Acquired with a NIDEK AFC-230; DR severity per modified Davis staging; color fundus image; nonmydriatic; 848x848; 45° FOV:
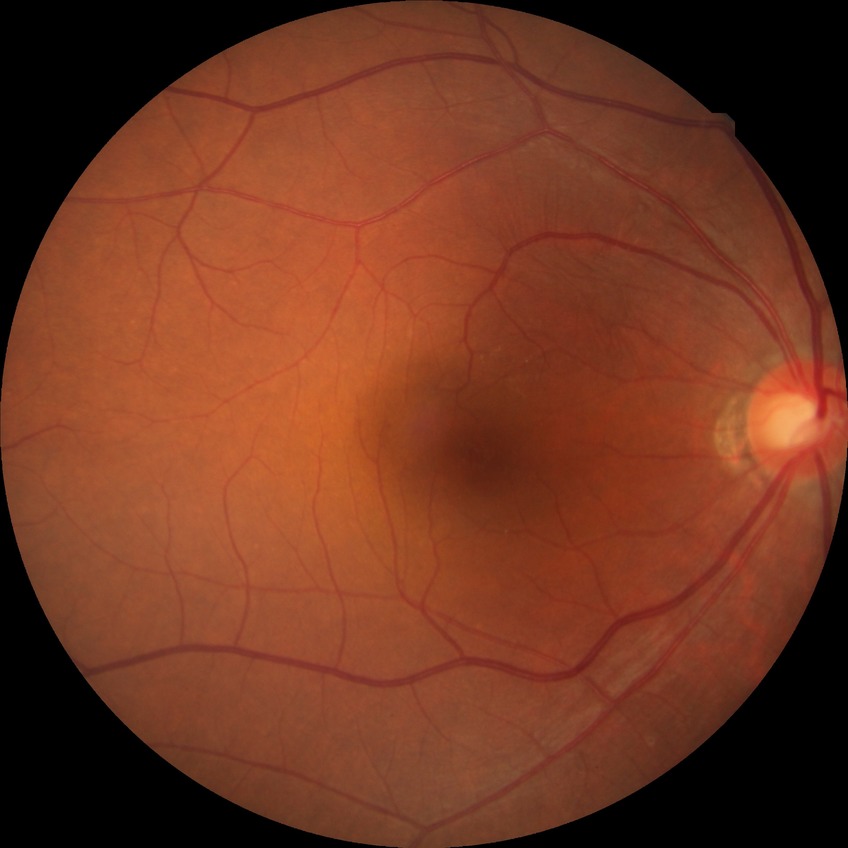

Diabetic retinopathy stage is no diabetic retinopathy.